45-degree field of view — 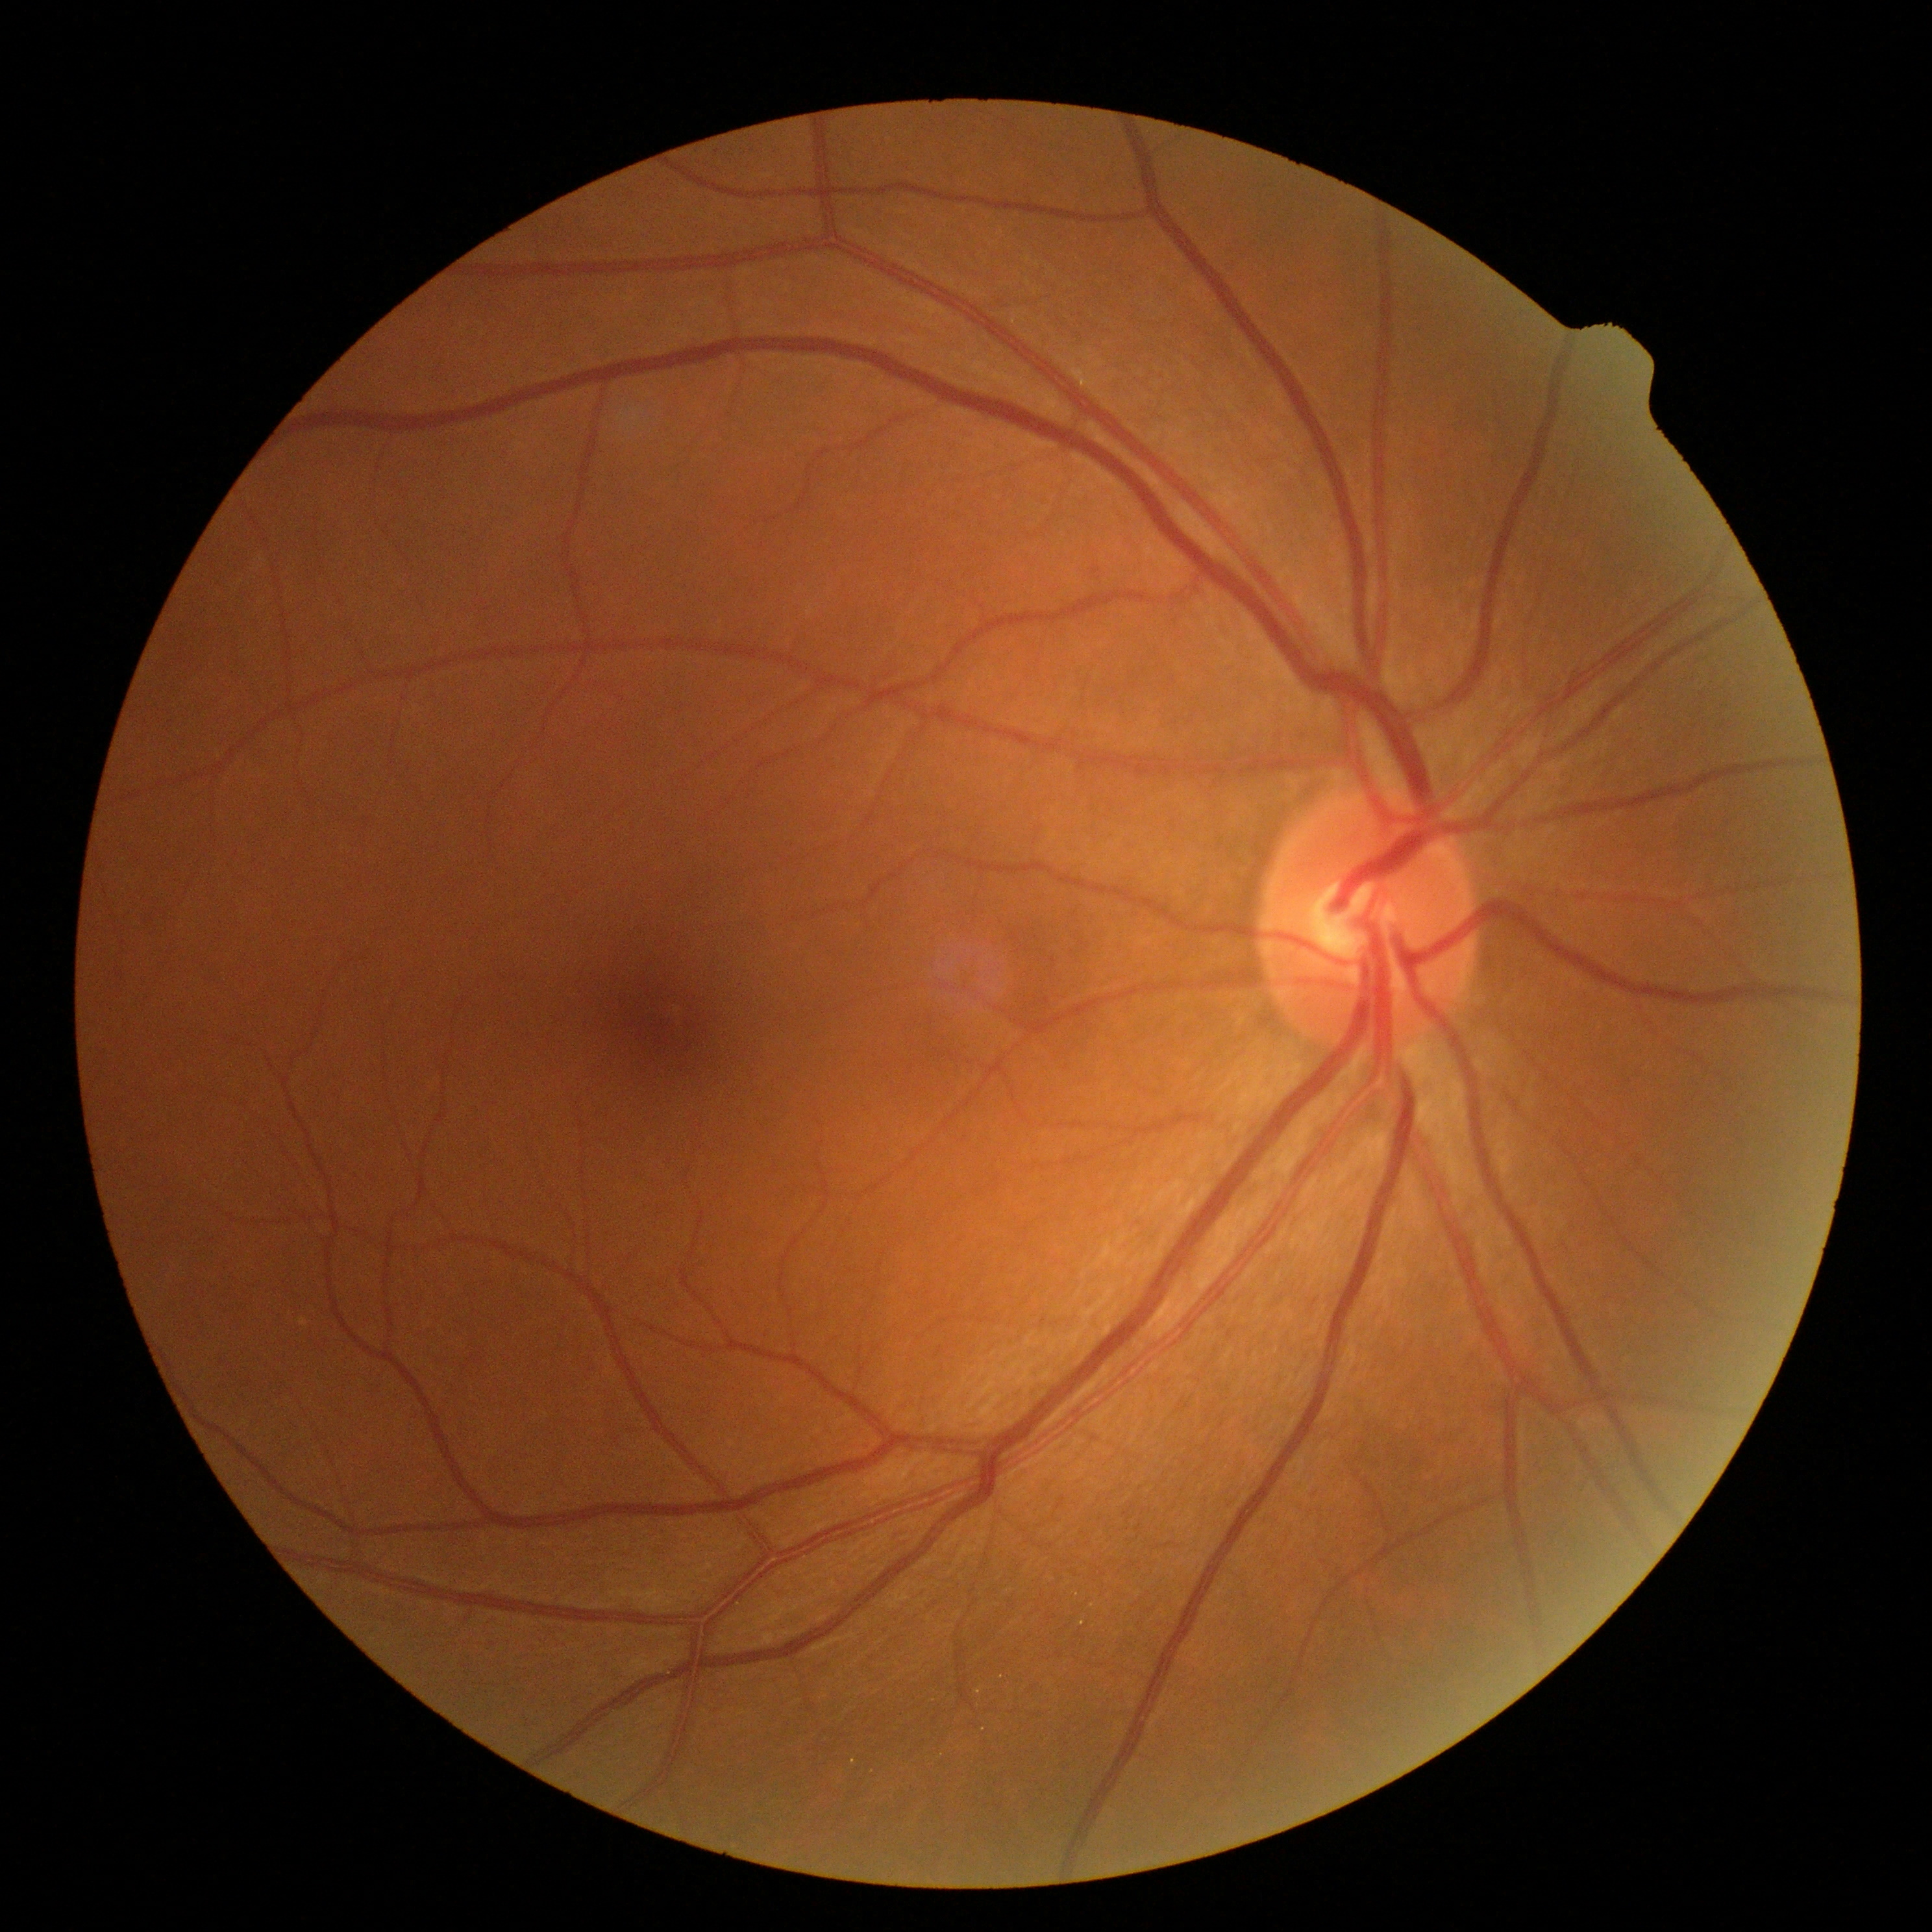 DR severity: no apparent diabetic retinopathy (grade 0) — no visible signs of diabetic retinopathy.